45-degree field of view. Without pupil dilation.
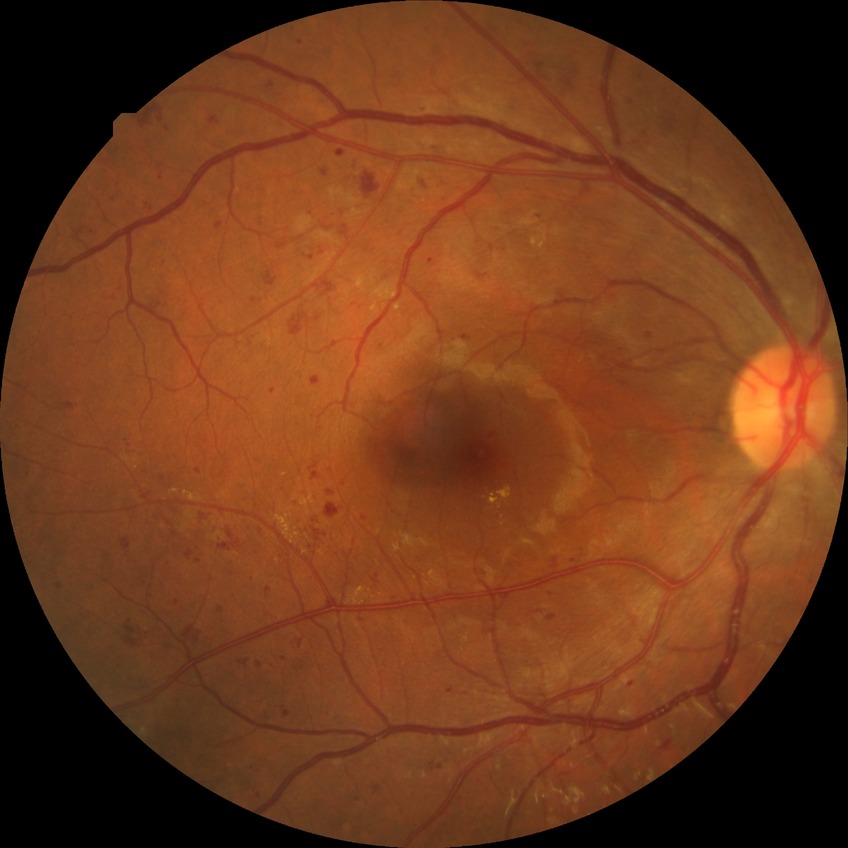

DR class = non-proliferative diabetic retinopathy | diabetic retinopathy (DR) = simple diabetic retinopathy (SDR).